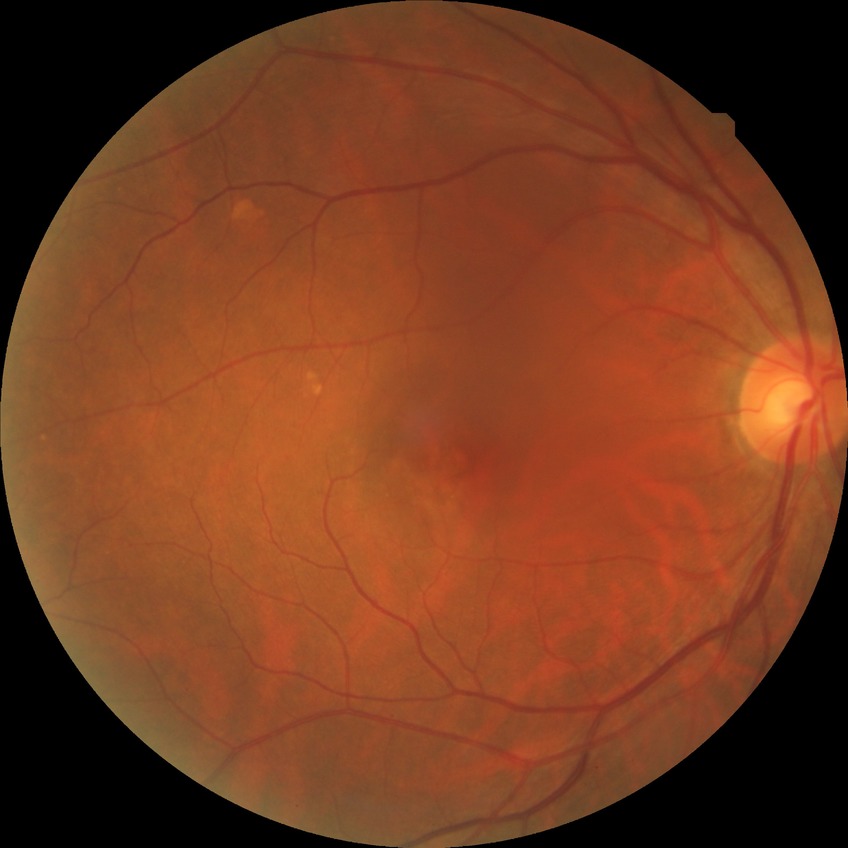
davis_grade: no diabetic retinopathy